Color fundus photograph.
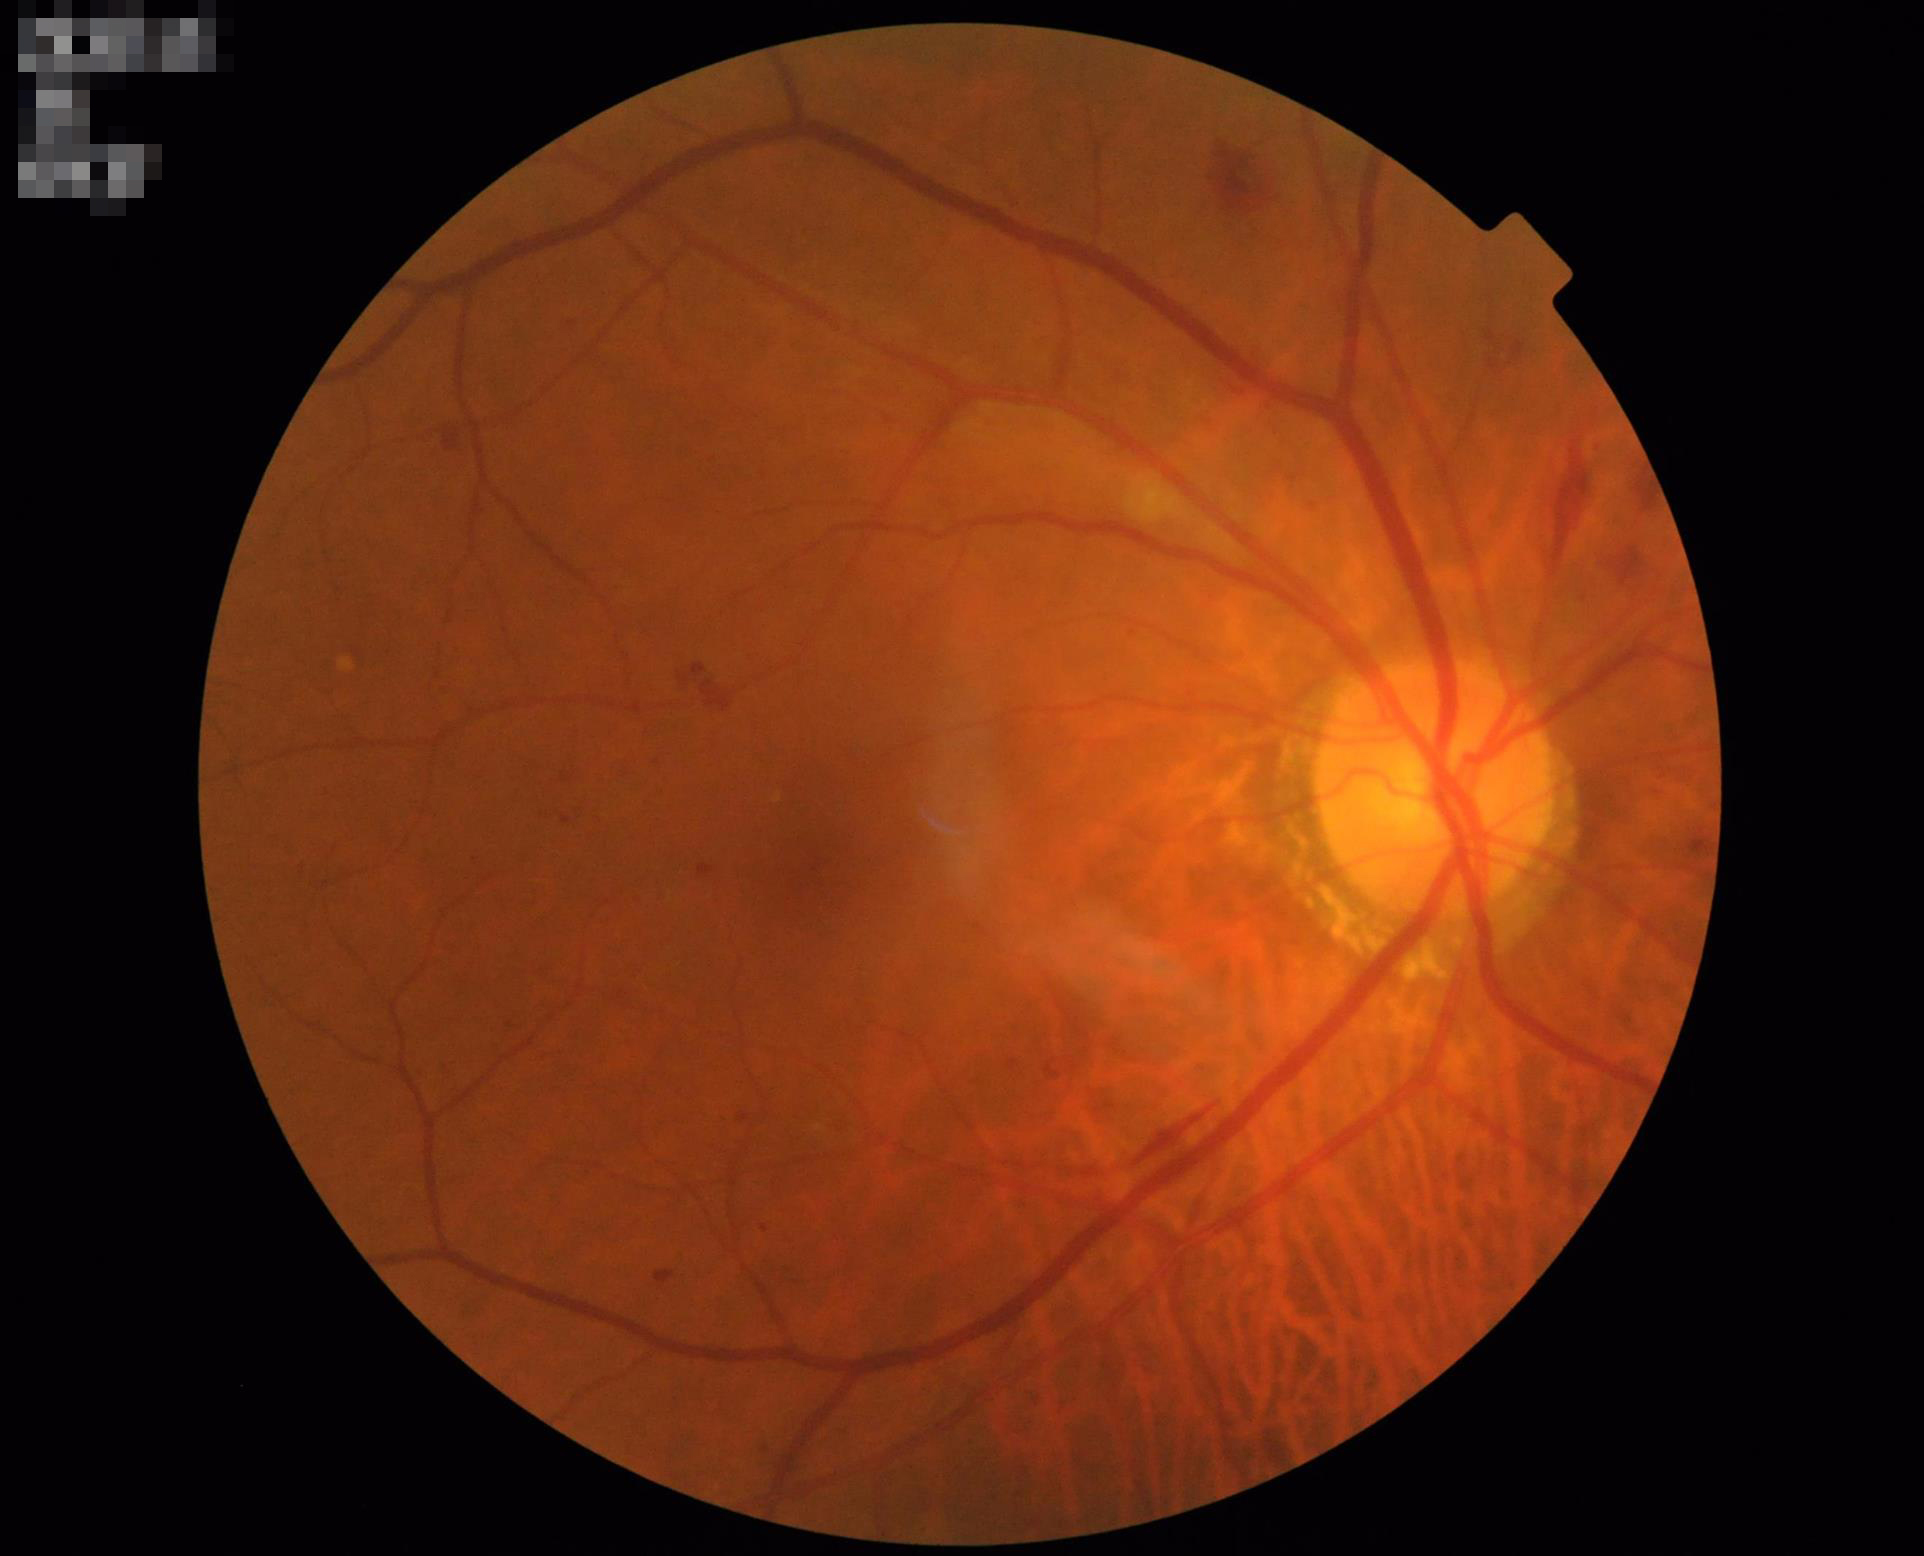
Acceptable image quality.
Good dynamic range.
Even illumination with no color cast.